45-degree field of view. CFP. Image size 2212x1659: 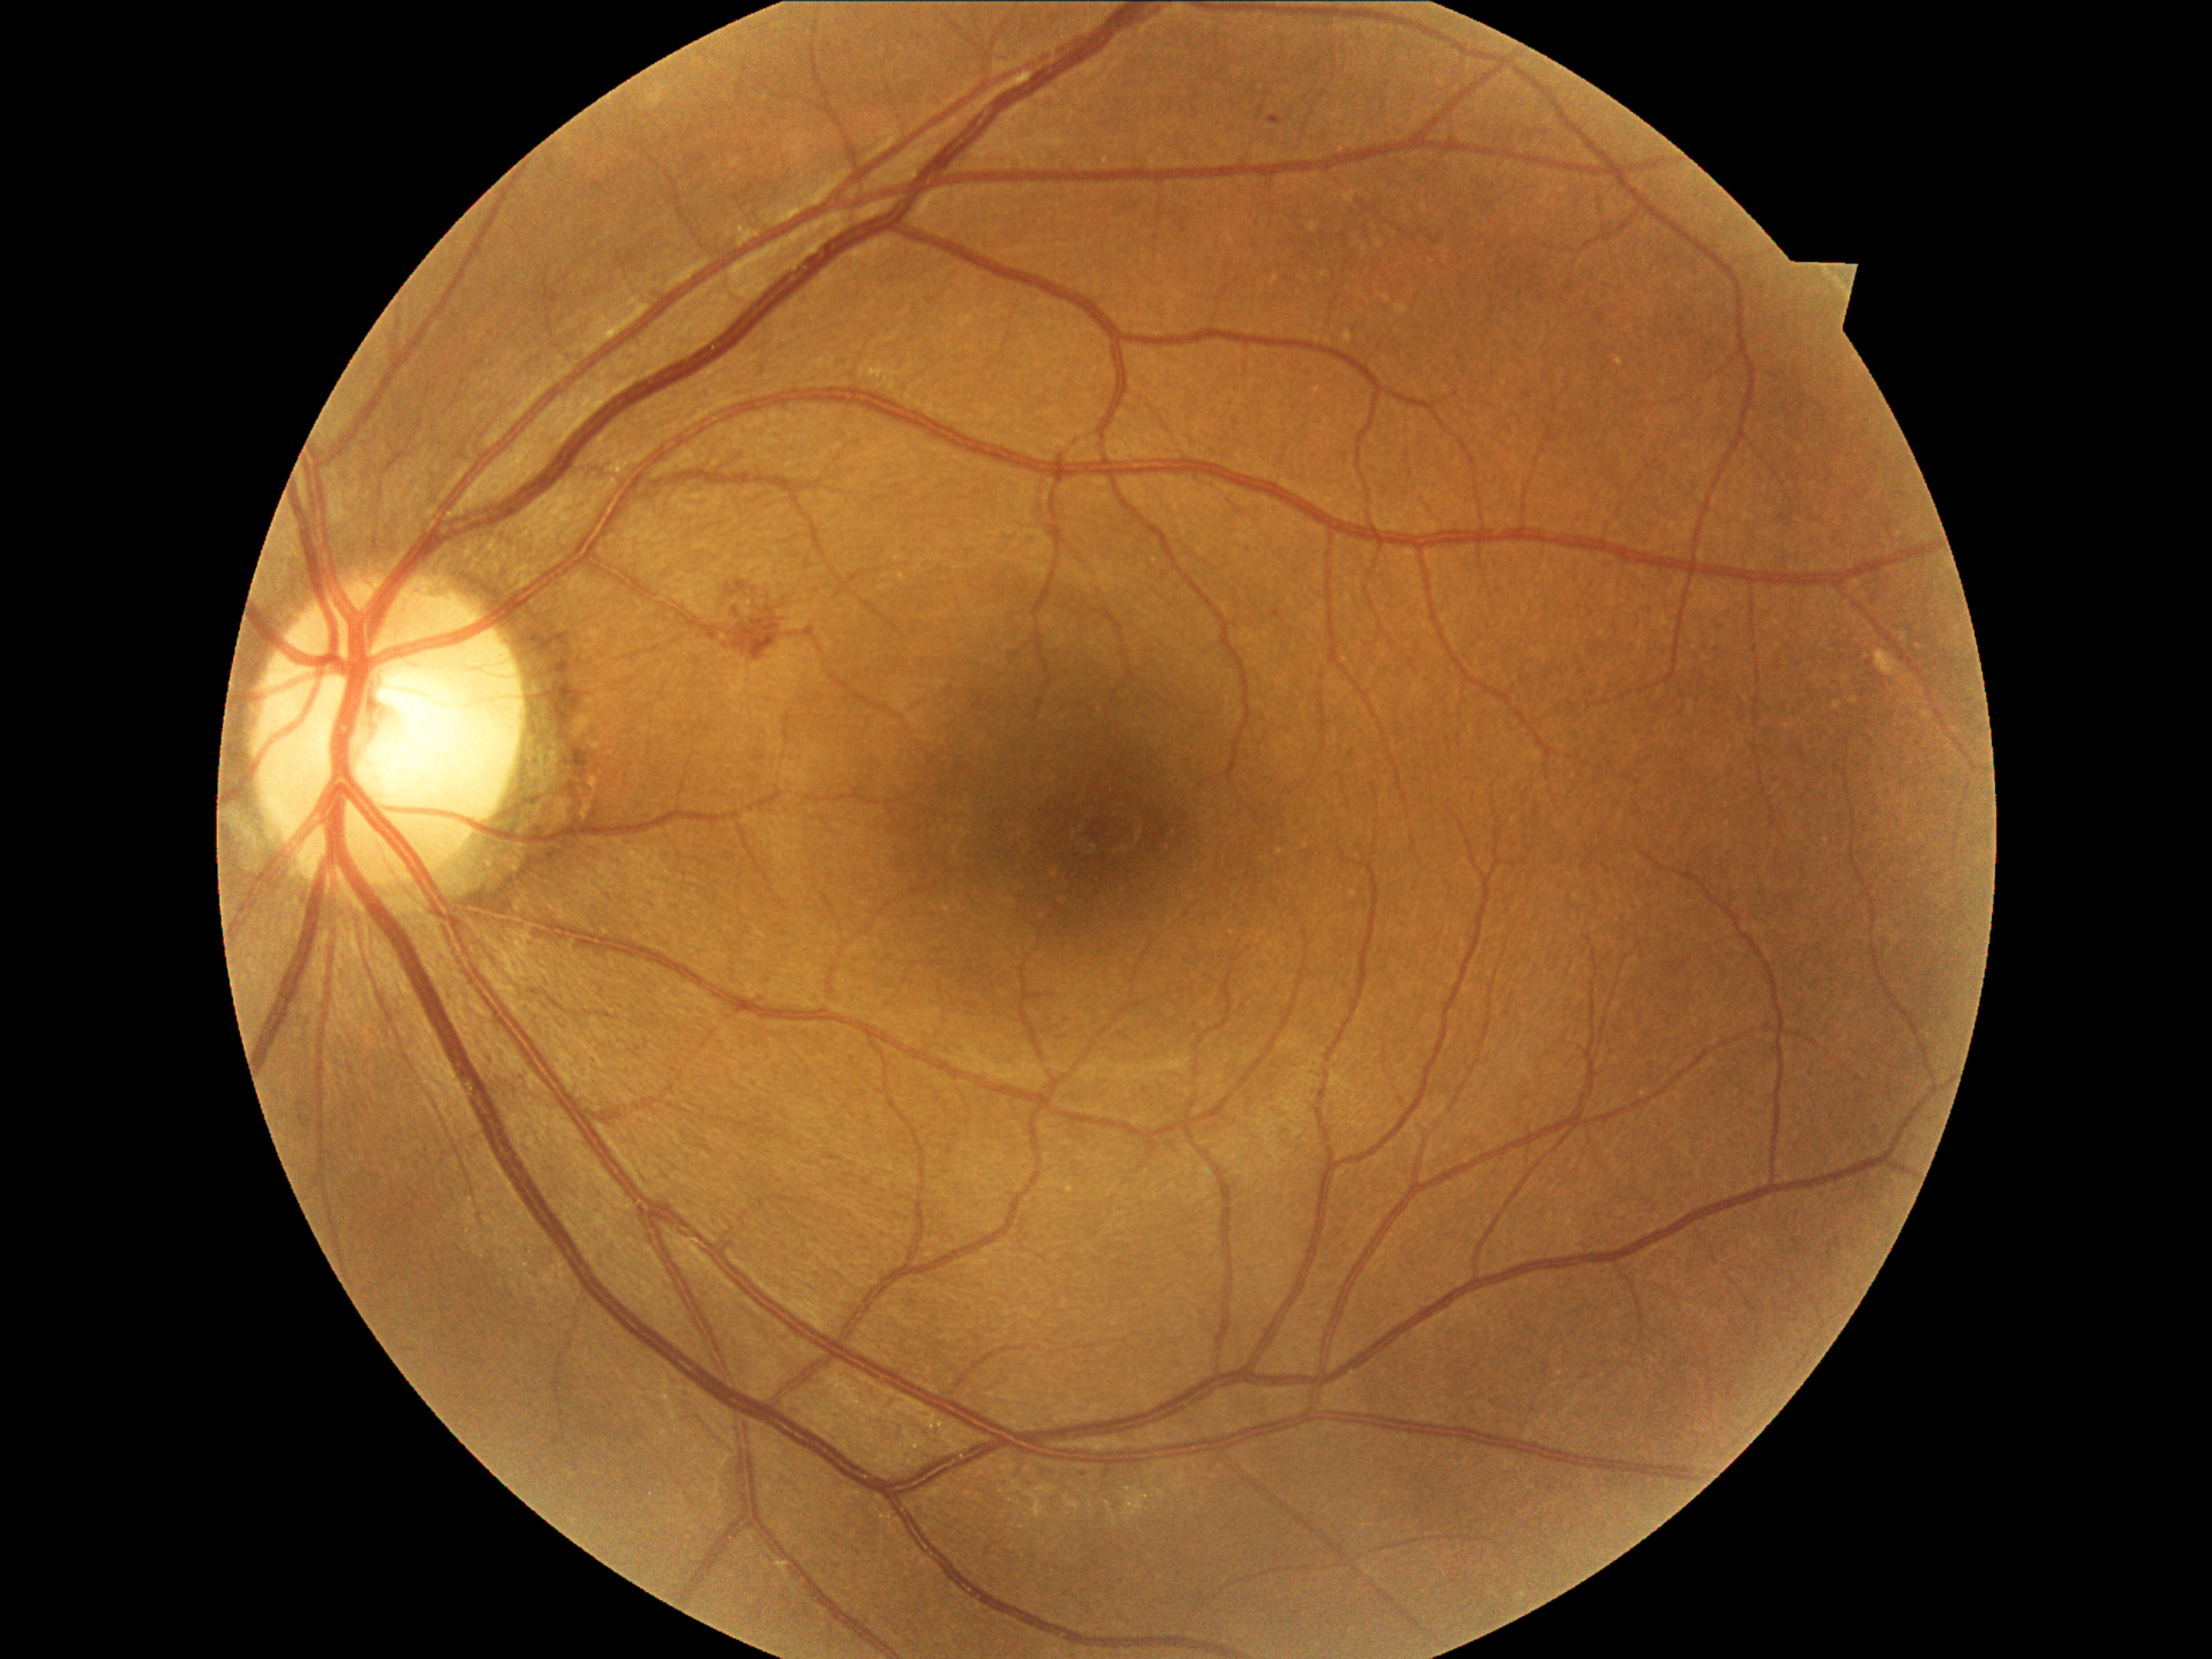 Retinopathy grade: 2 (moderate NPDR); non-proliferative diabetic retinopathy
A subset of detected lesions:
microaneurysms (more not shown) = BBox(1269, 115, 1283, 124), BBox(487, 1054, 498, 1064)
hard exudates = none identified
hemorrhages = BBox(733, 578, 791, 656)
soft exudates = none identified